CFP: 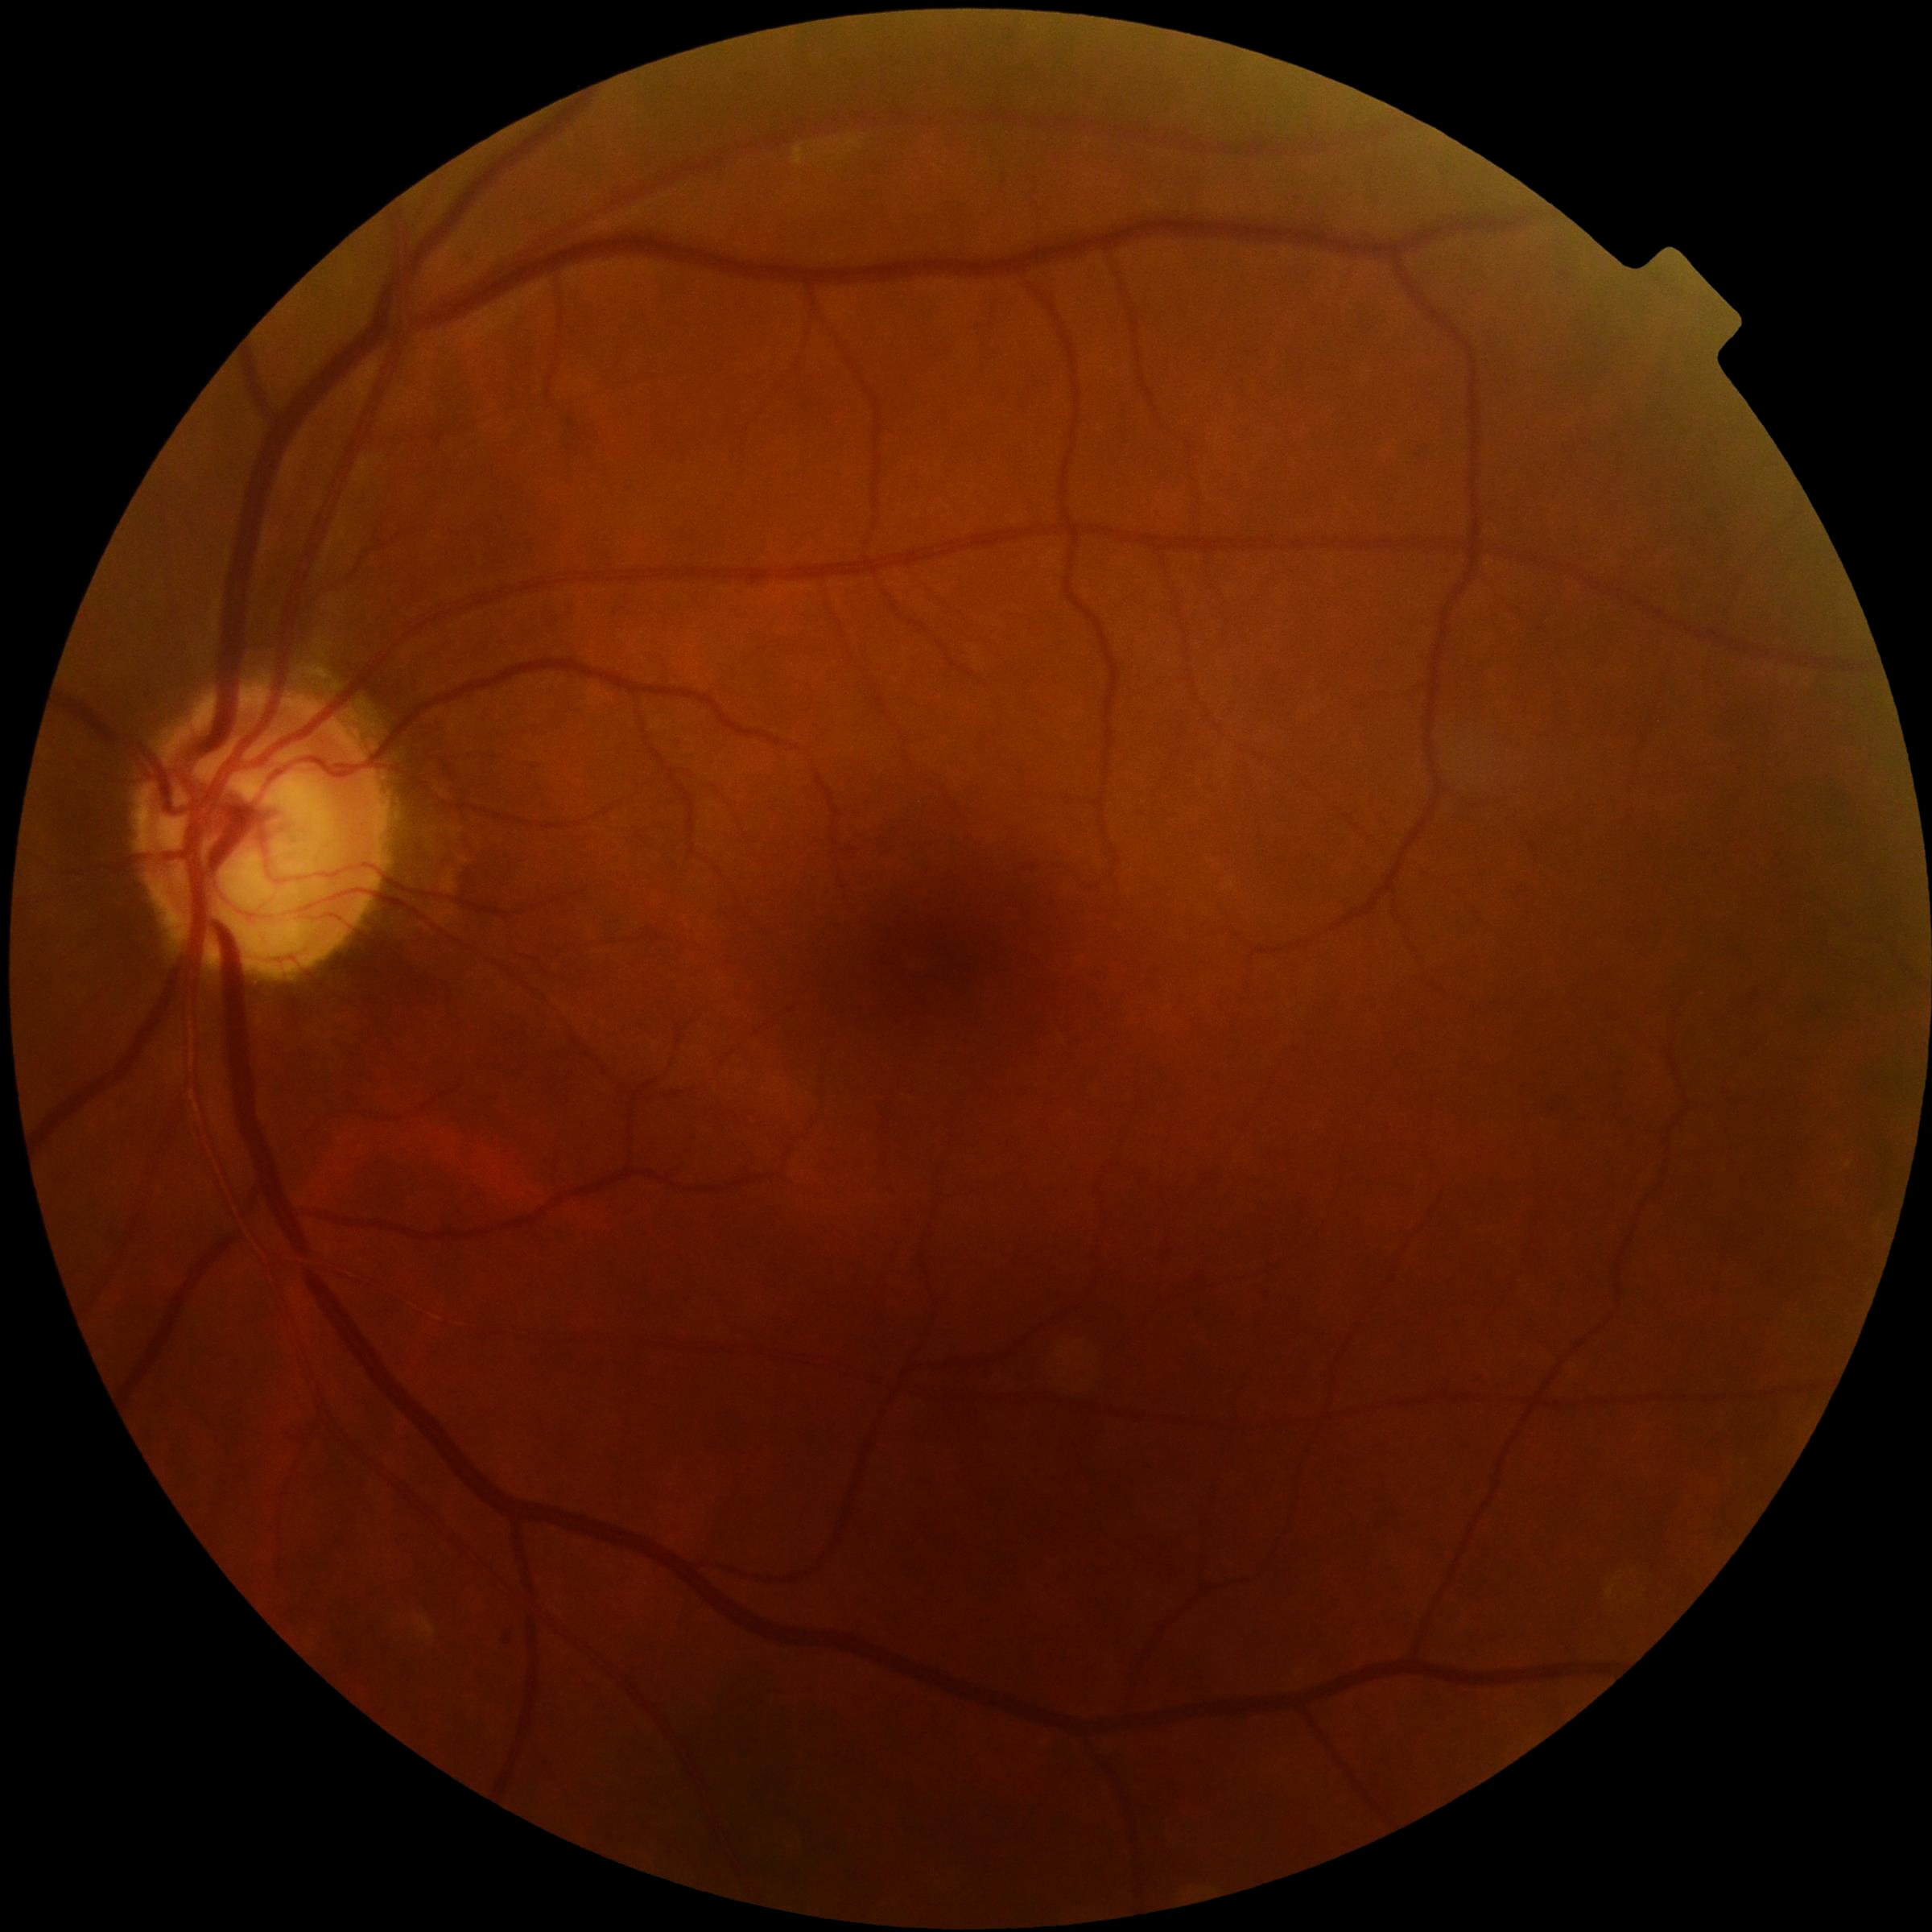

DR class: non-proliferative diabetic retinopathy, DR: grade 1 (mild NPDR) — presence of microaneurysms only.